No pharmacologic dilation; image size 848x848; color fundus image: 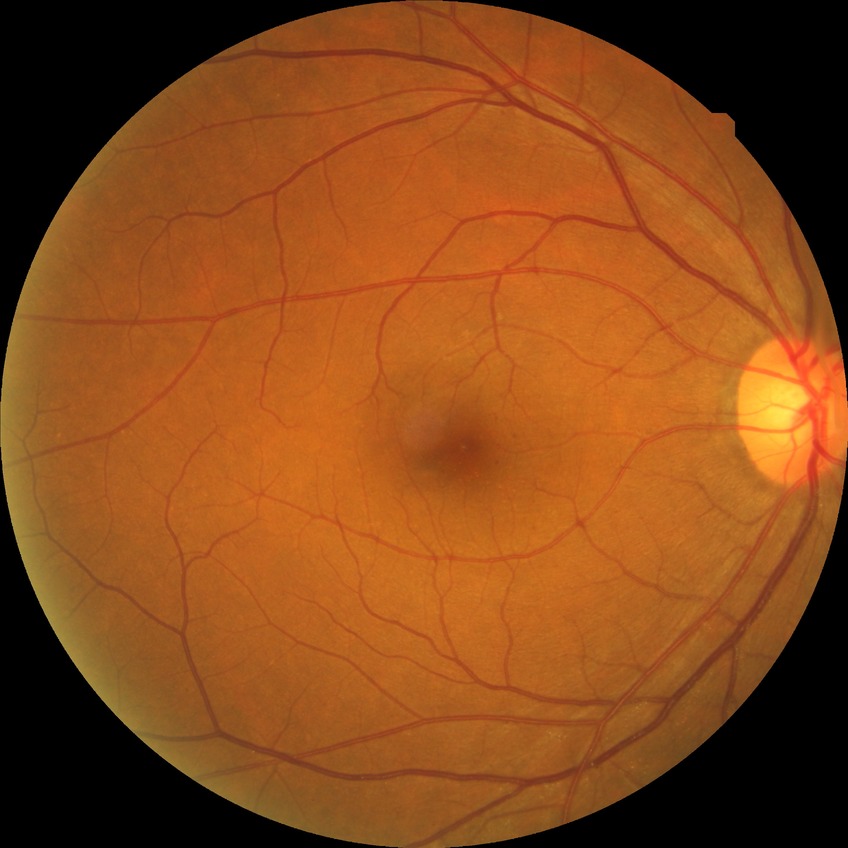 – Davis grading: simple diabetic retinopathy